848 x 848 pixels · fundus photo · 45° FOV:
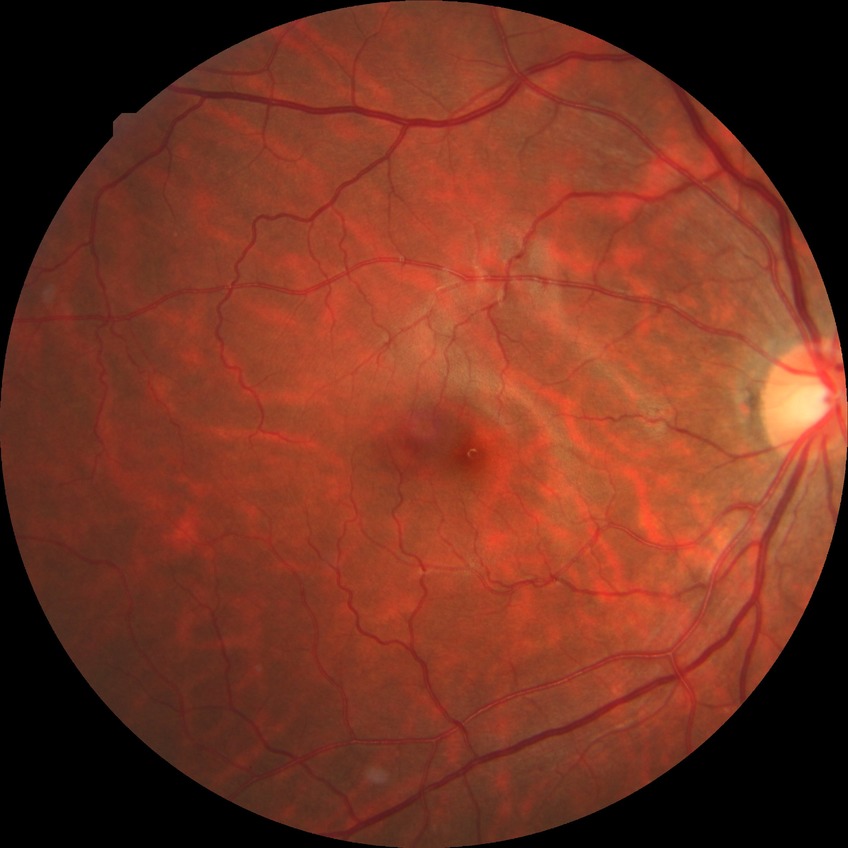
Davis stage is NDR.